FOV: 45 degrees — 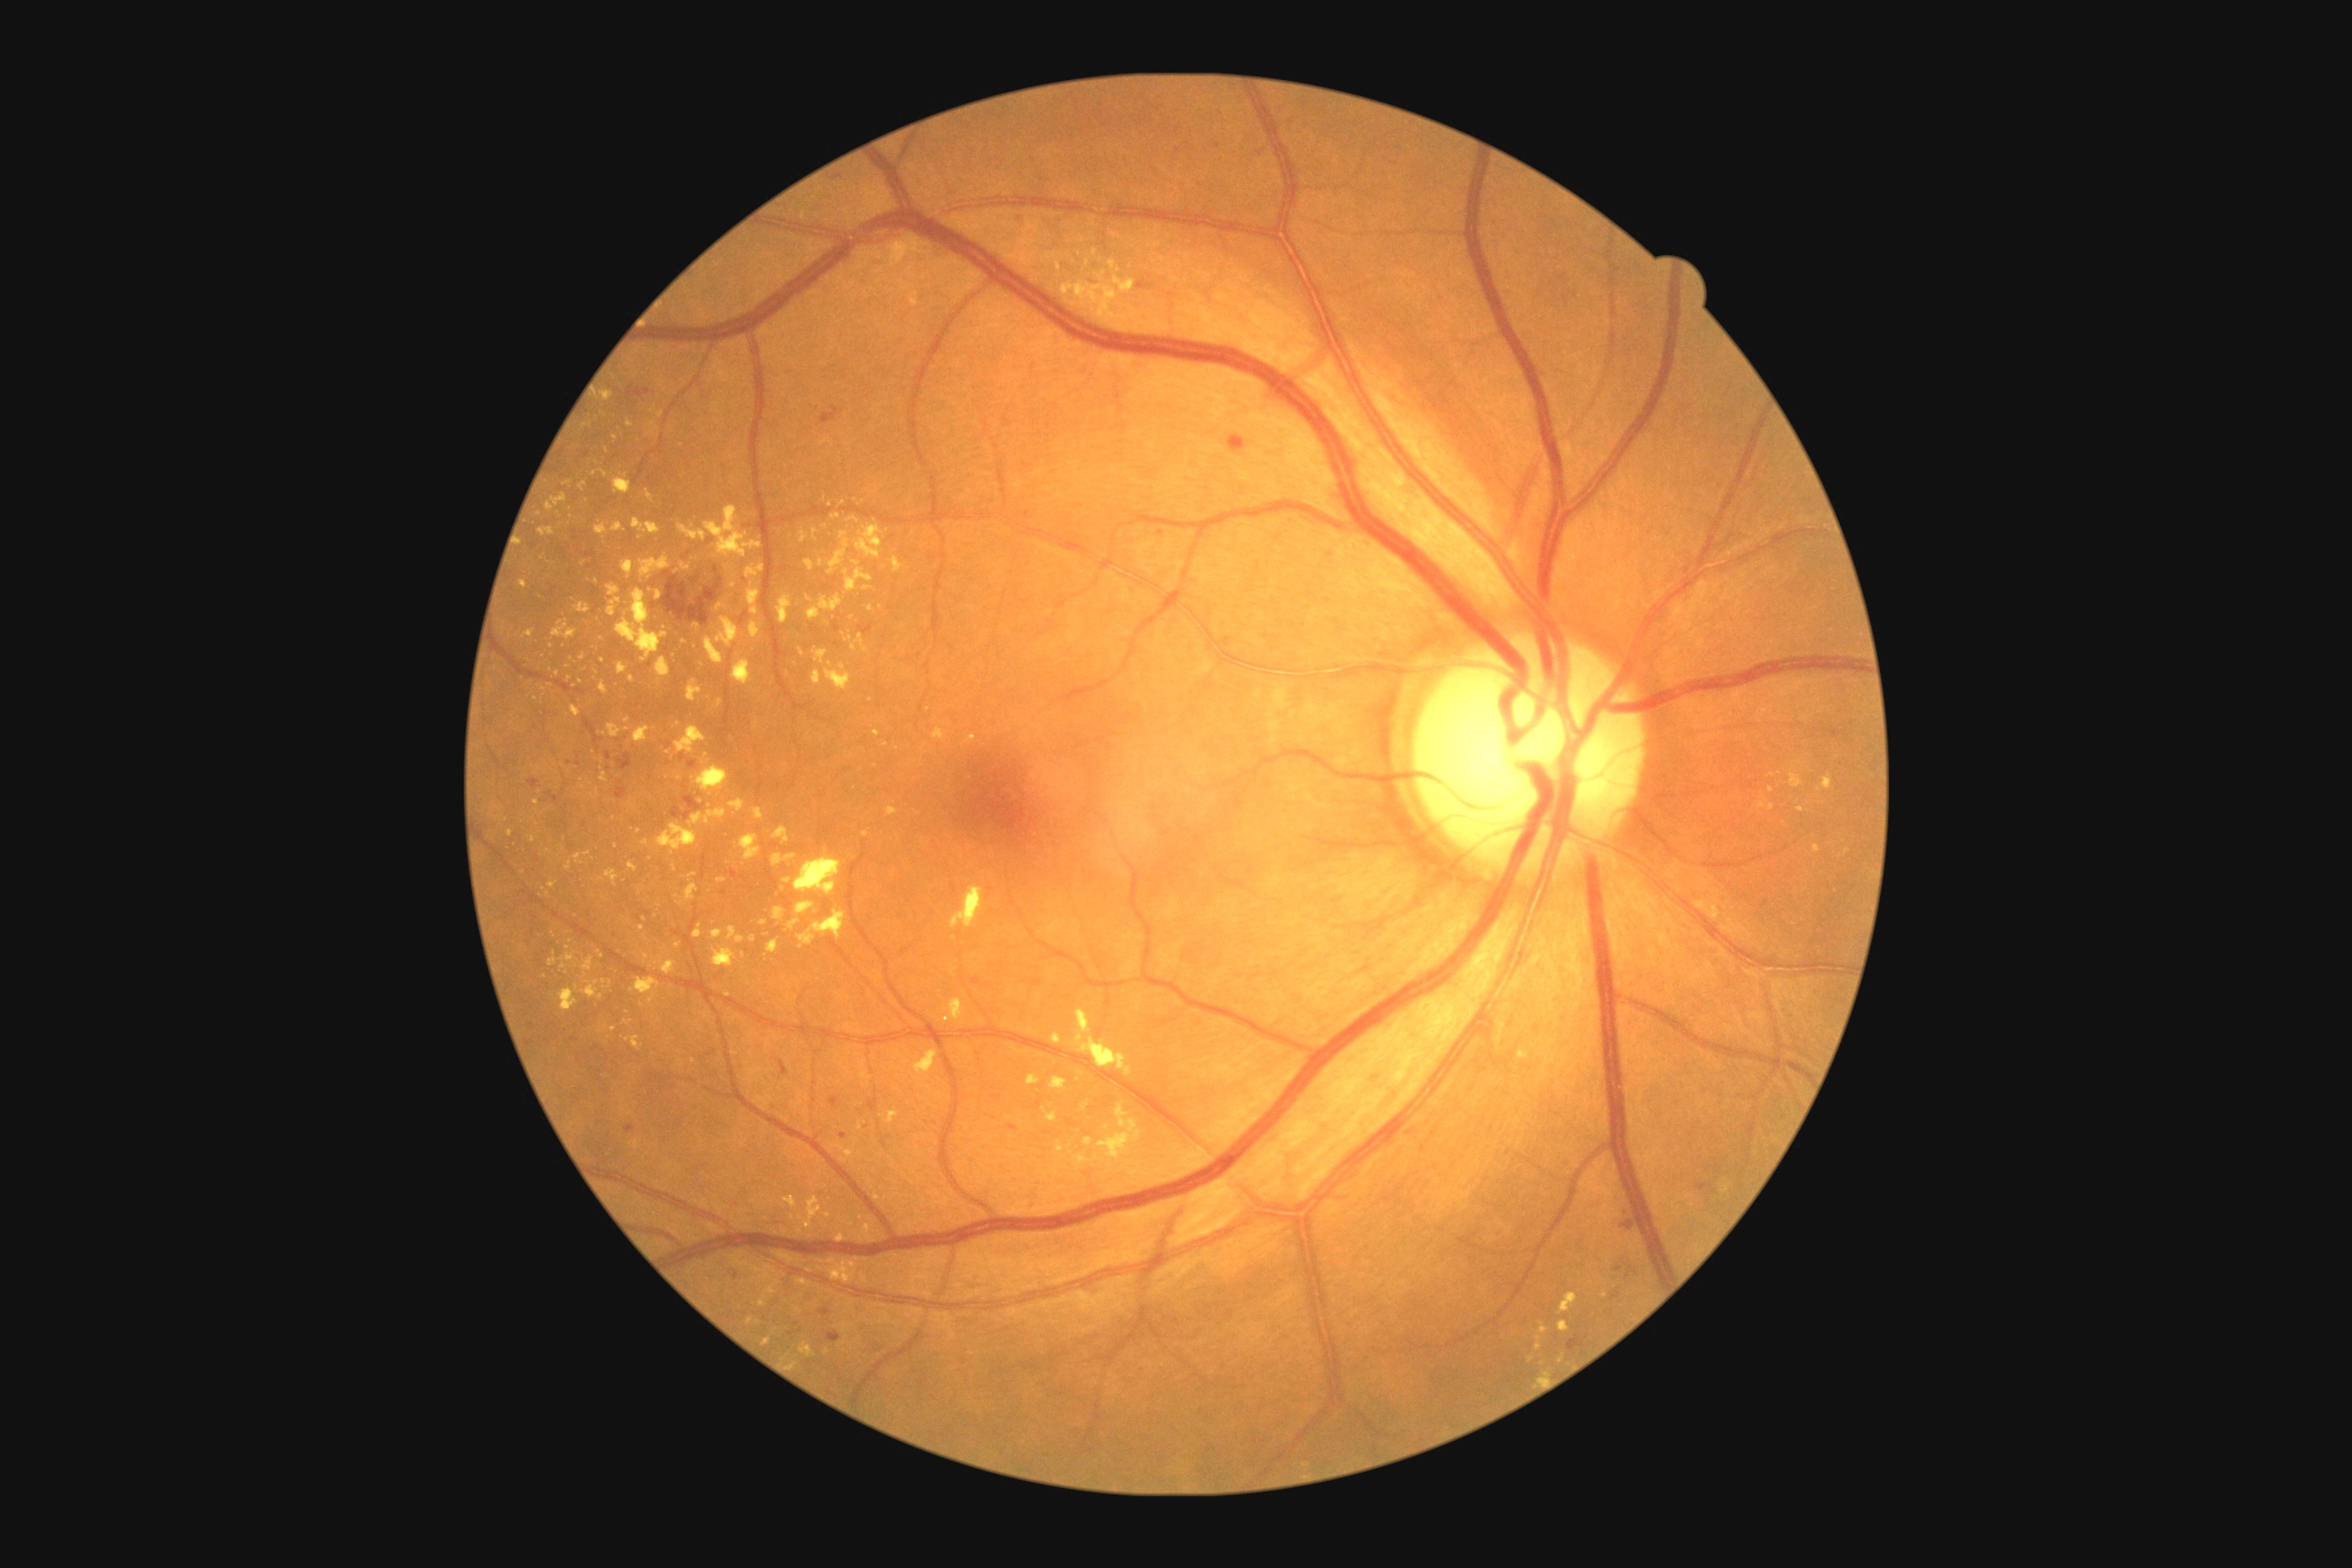

DR grade: 2 (moderate NPDR); non-proliferative diabetic retinopathy
Lesions identified (partial list):
EXs (more not shown): (600, 471, 609, 478); (643, 954, 649, 963); (1823, 776, 1834, 790); (625, 1035, 642, 1052); (703, 507, 761, 558); (574, 852, 591, 865); (845, 569, 874, 593); (522, 631, 534, 638); (805, 560, 816, 571); (547, 495, 569, 513)
Small EXs approximately at (570, 678); (728, 994); (785, 1233); (862, 1217); (632, 679); (928, 710); (543, 557); (607, 451); (1101, 260)